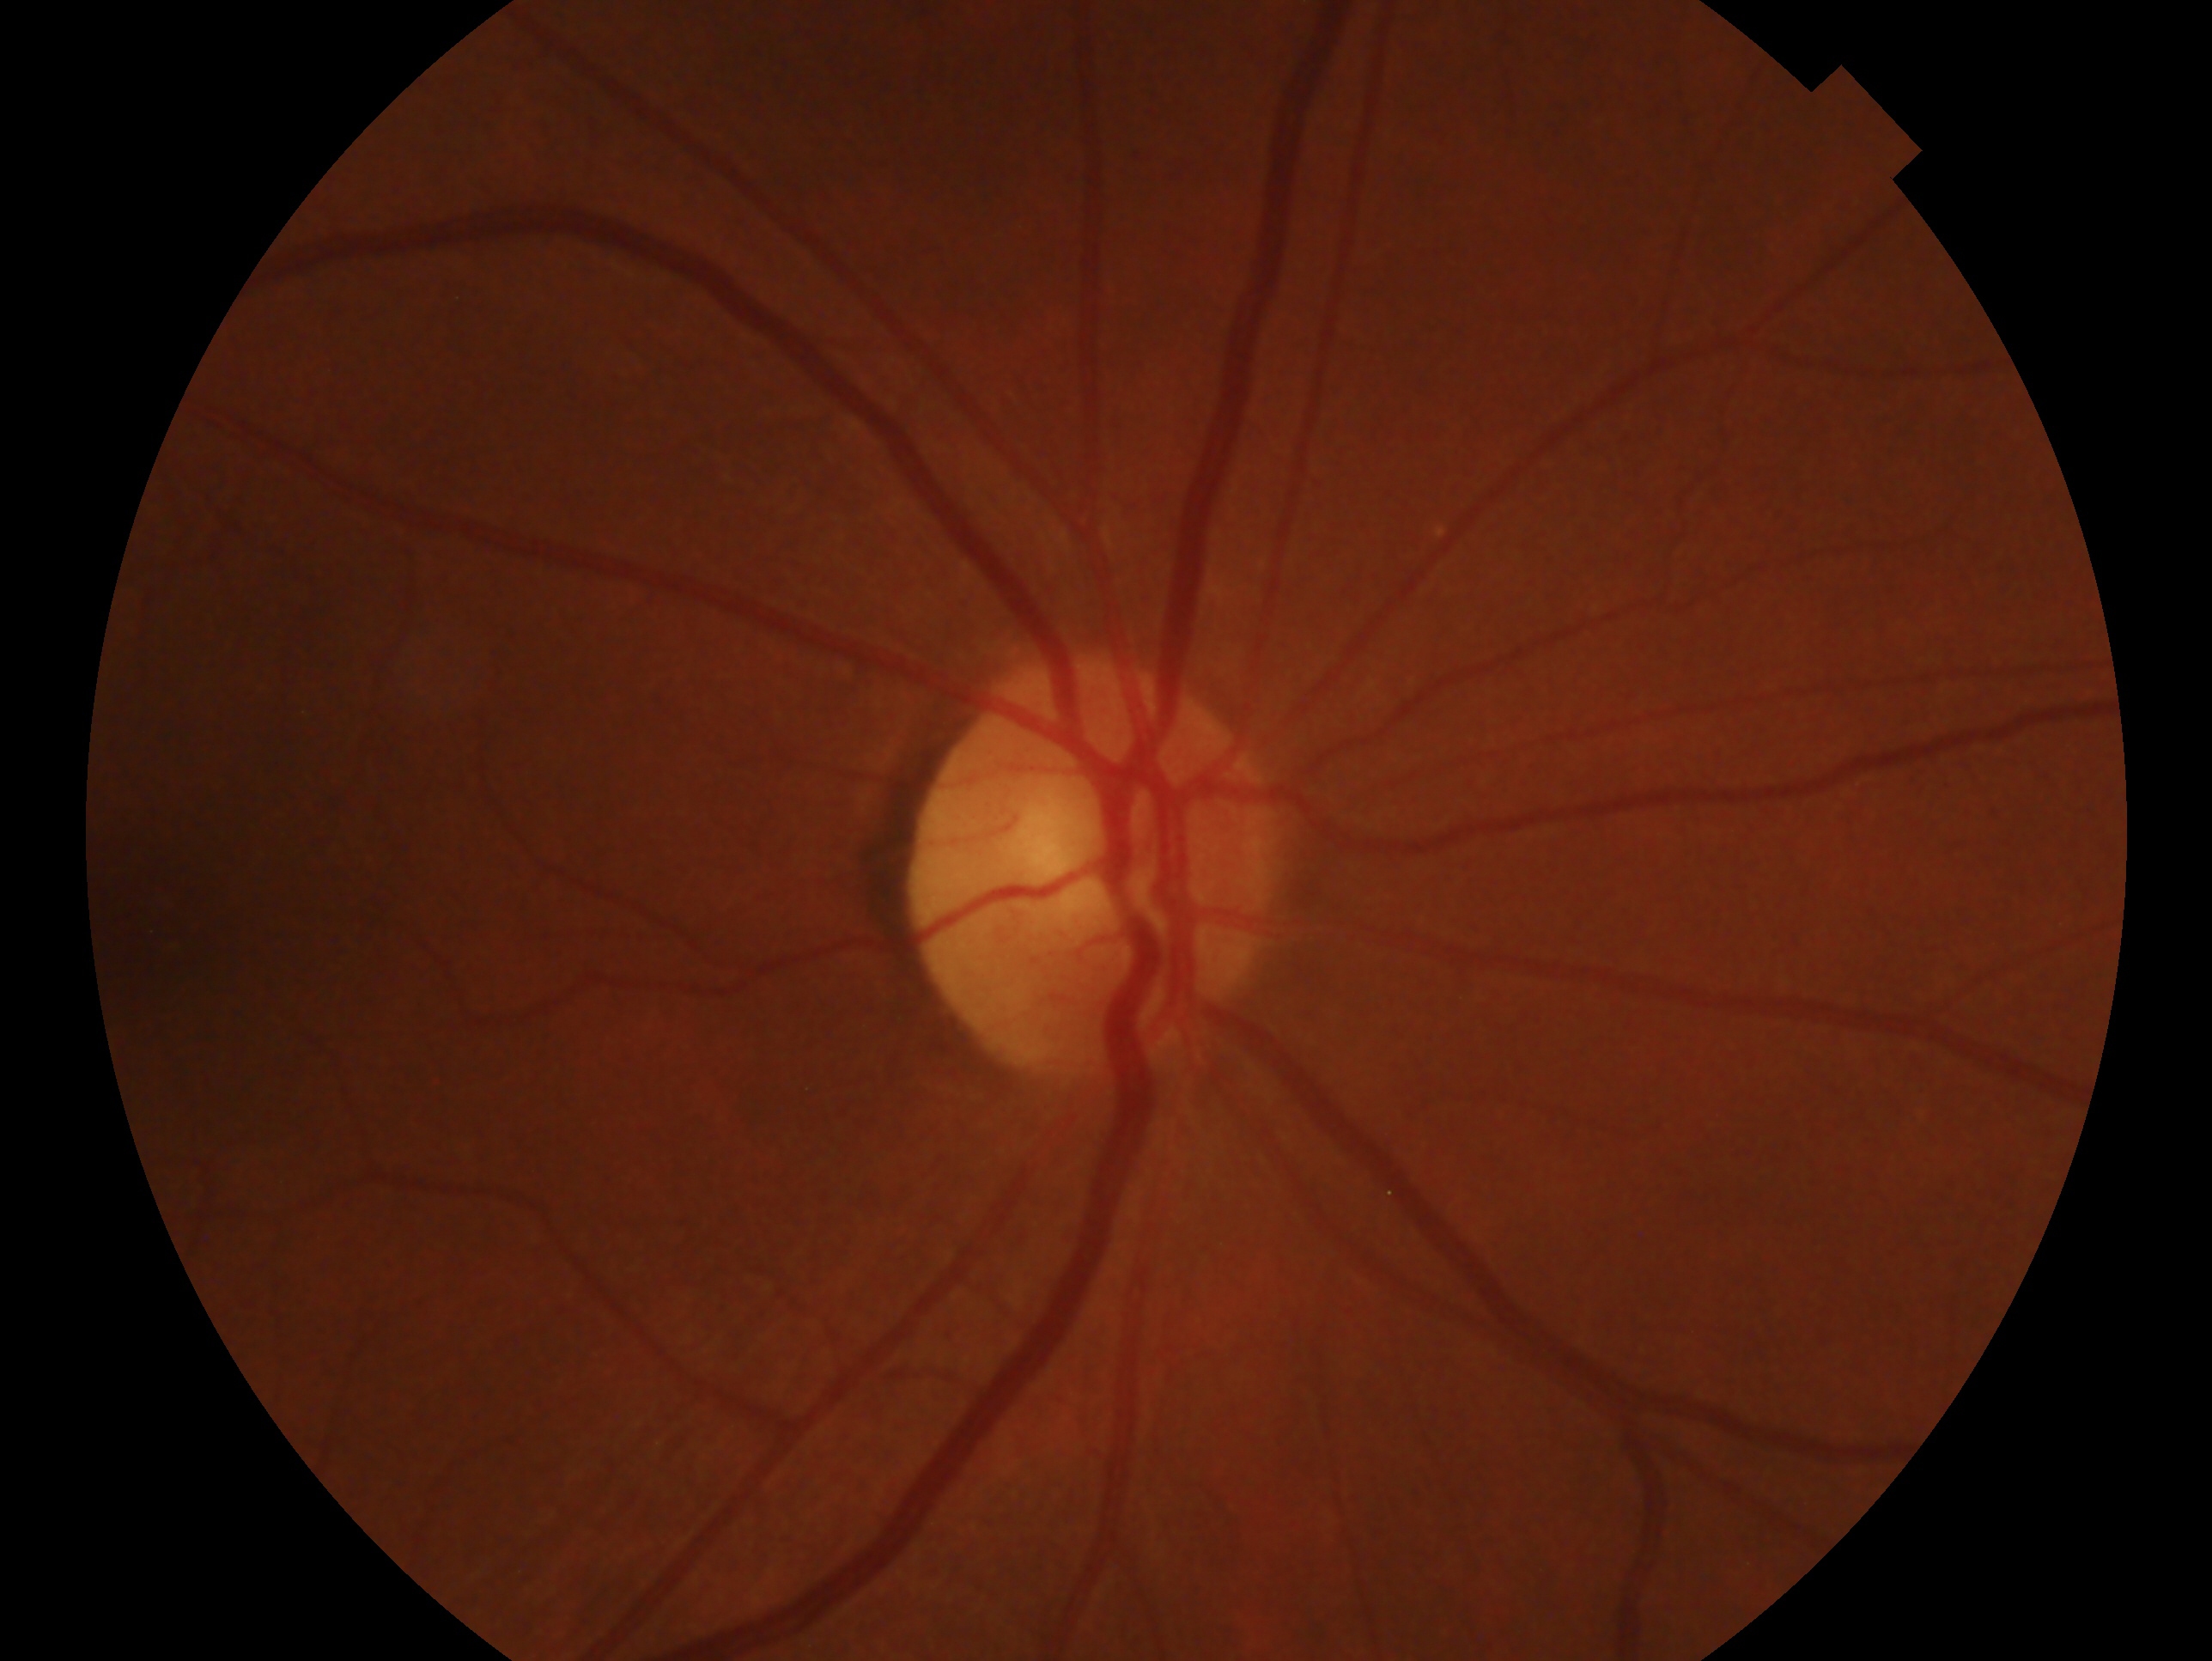 eye: OD, impression: no evidence of glaucoma.